No pharmacologic dilation · CFP · NIDEK AFC-230 fundus camera · FOV: 45 degrees.
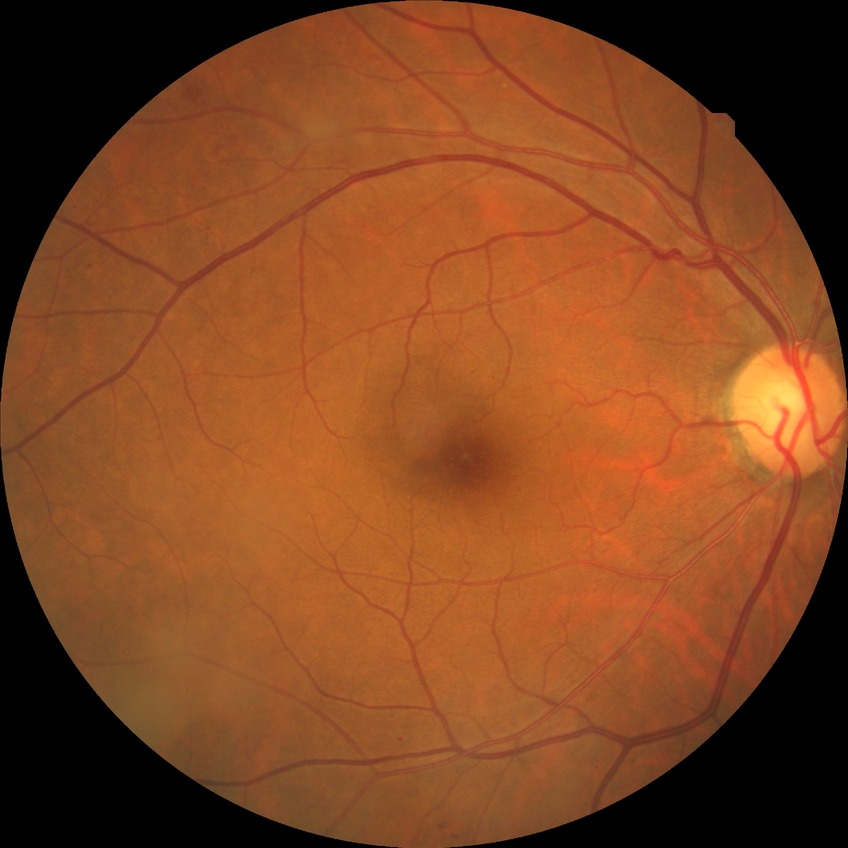
Annotations:
• diabetic retinopathy (DR) — simple diabetic retinopathy (SDR)